CFP:
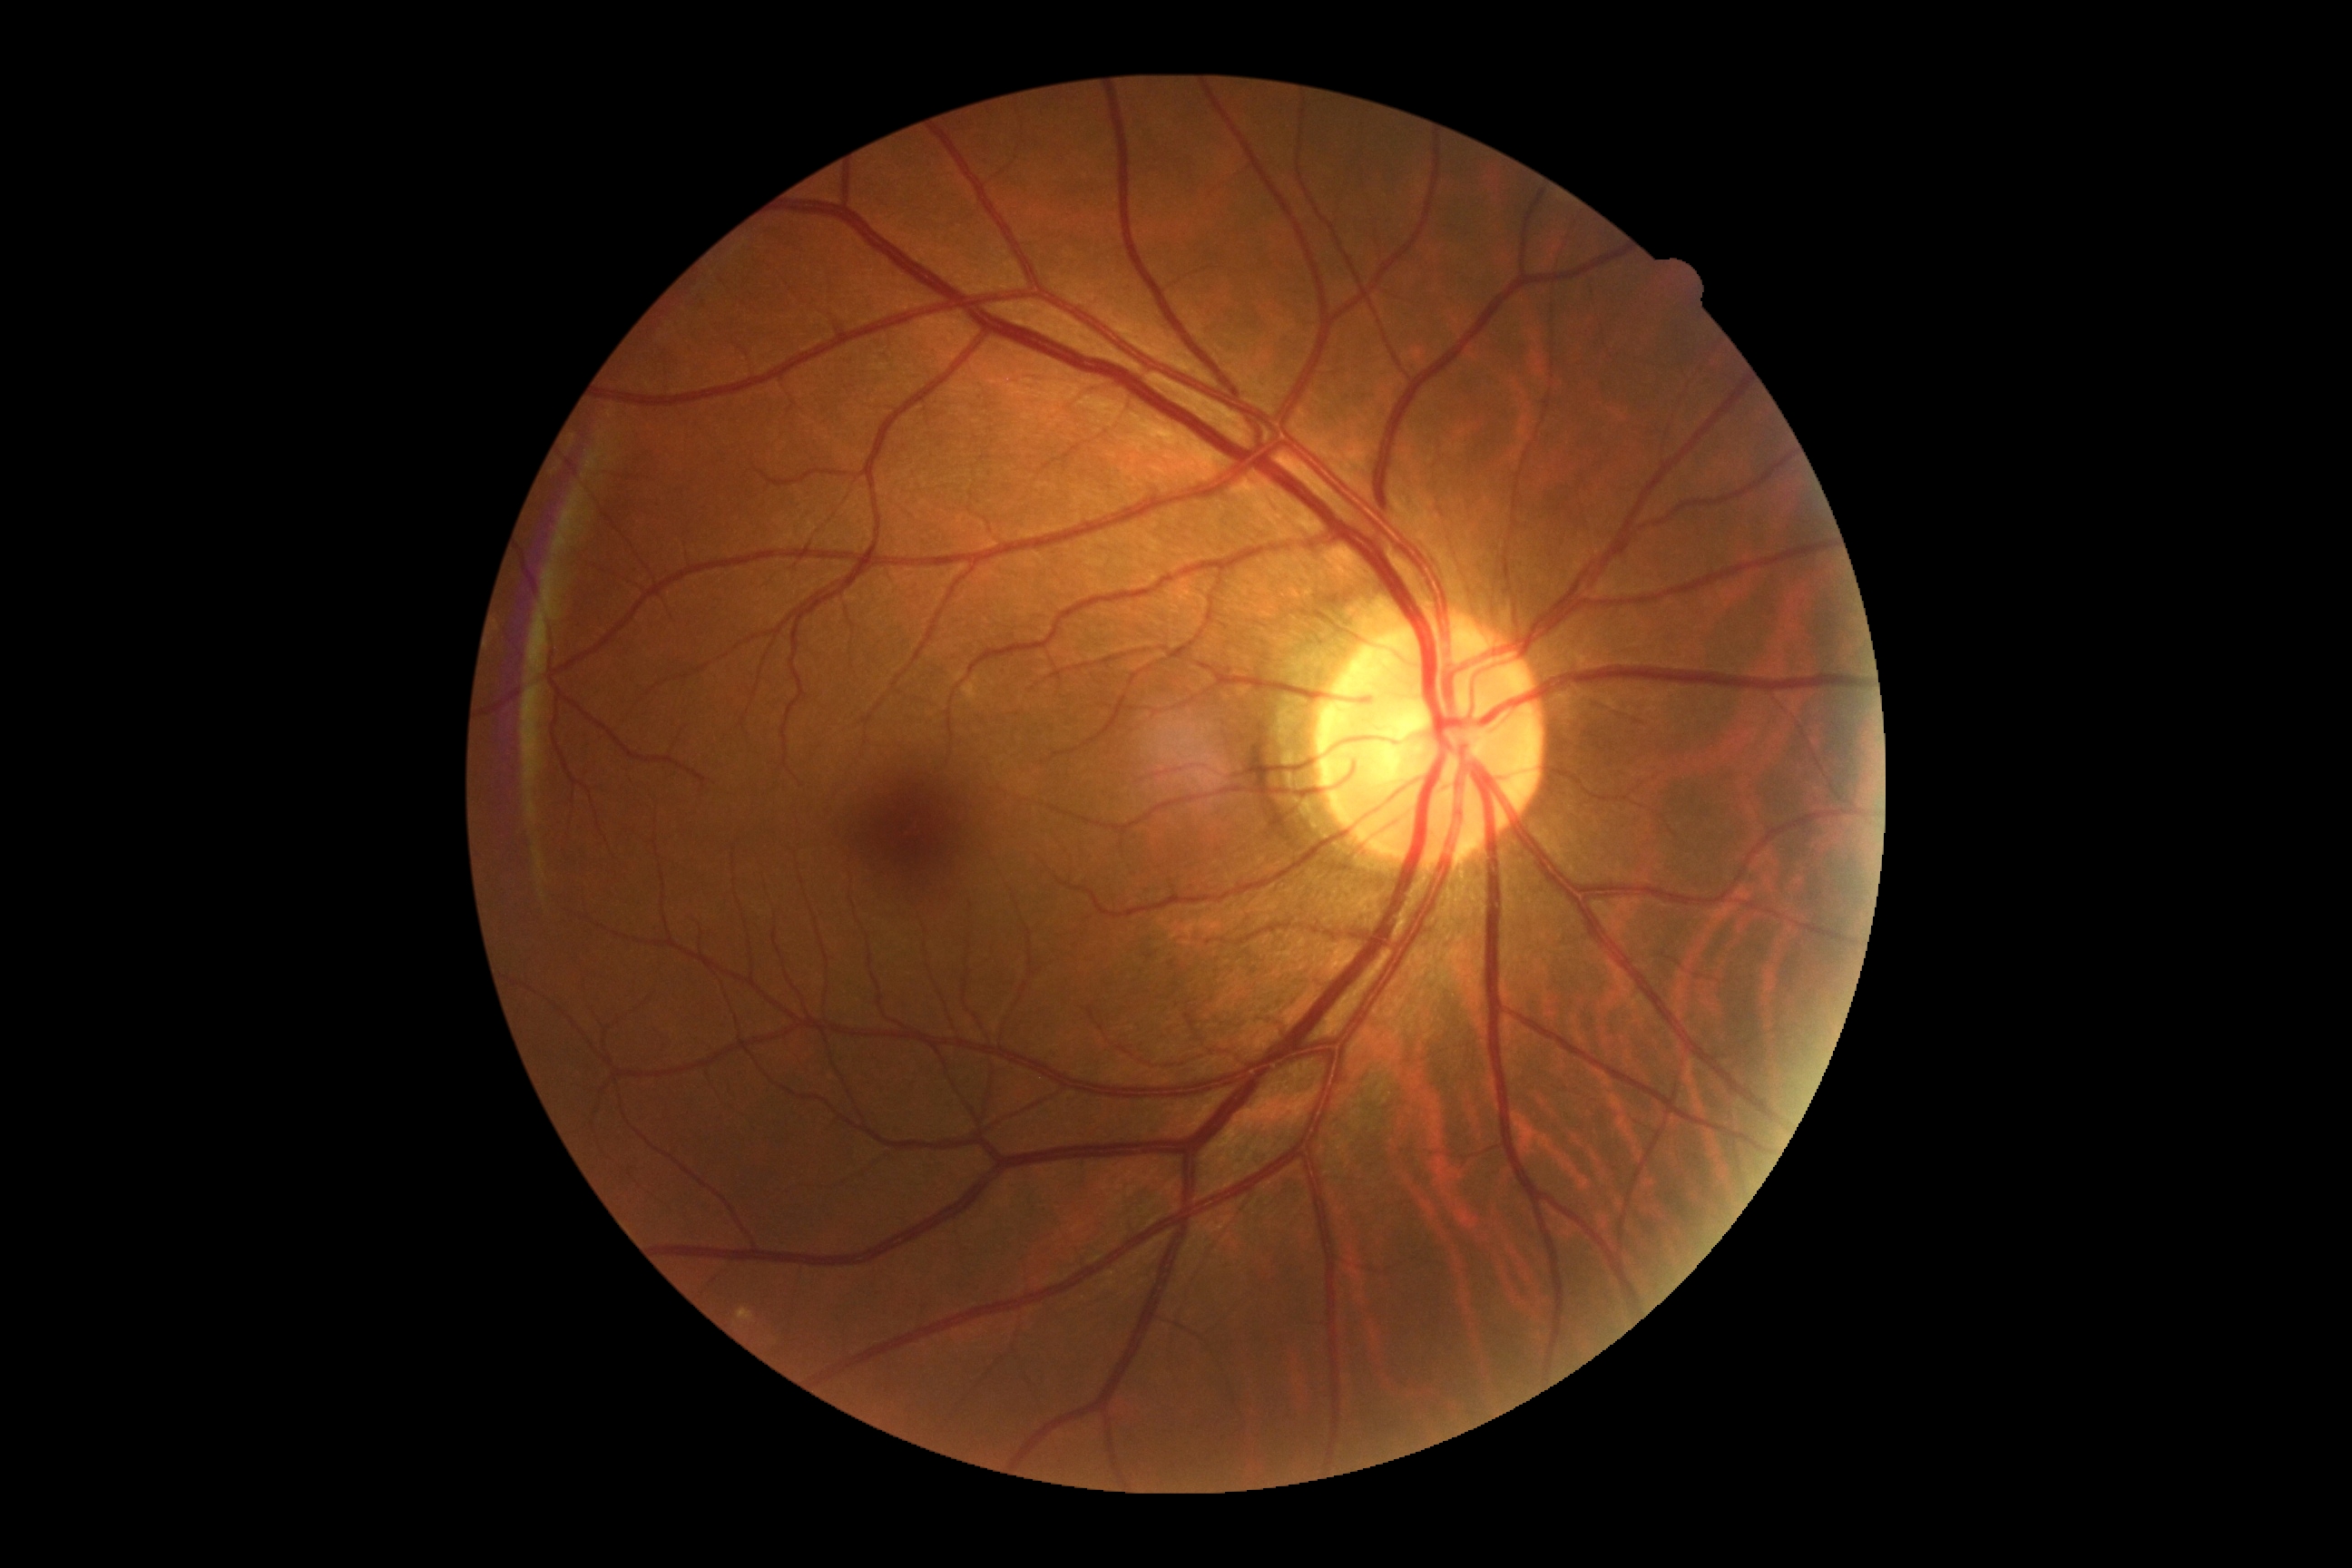 DR grade: 0/4.